2352 x 1568 pixels; 45-degree field of view; fundus photo:
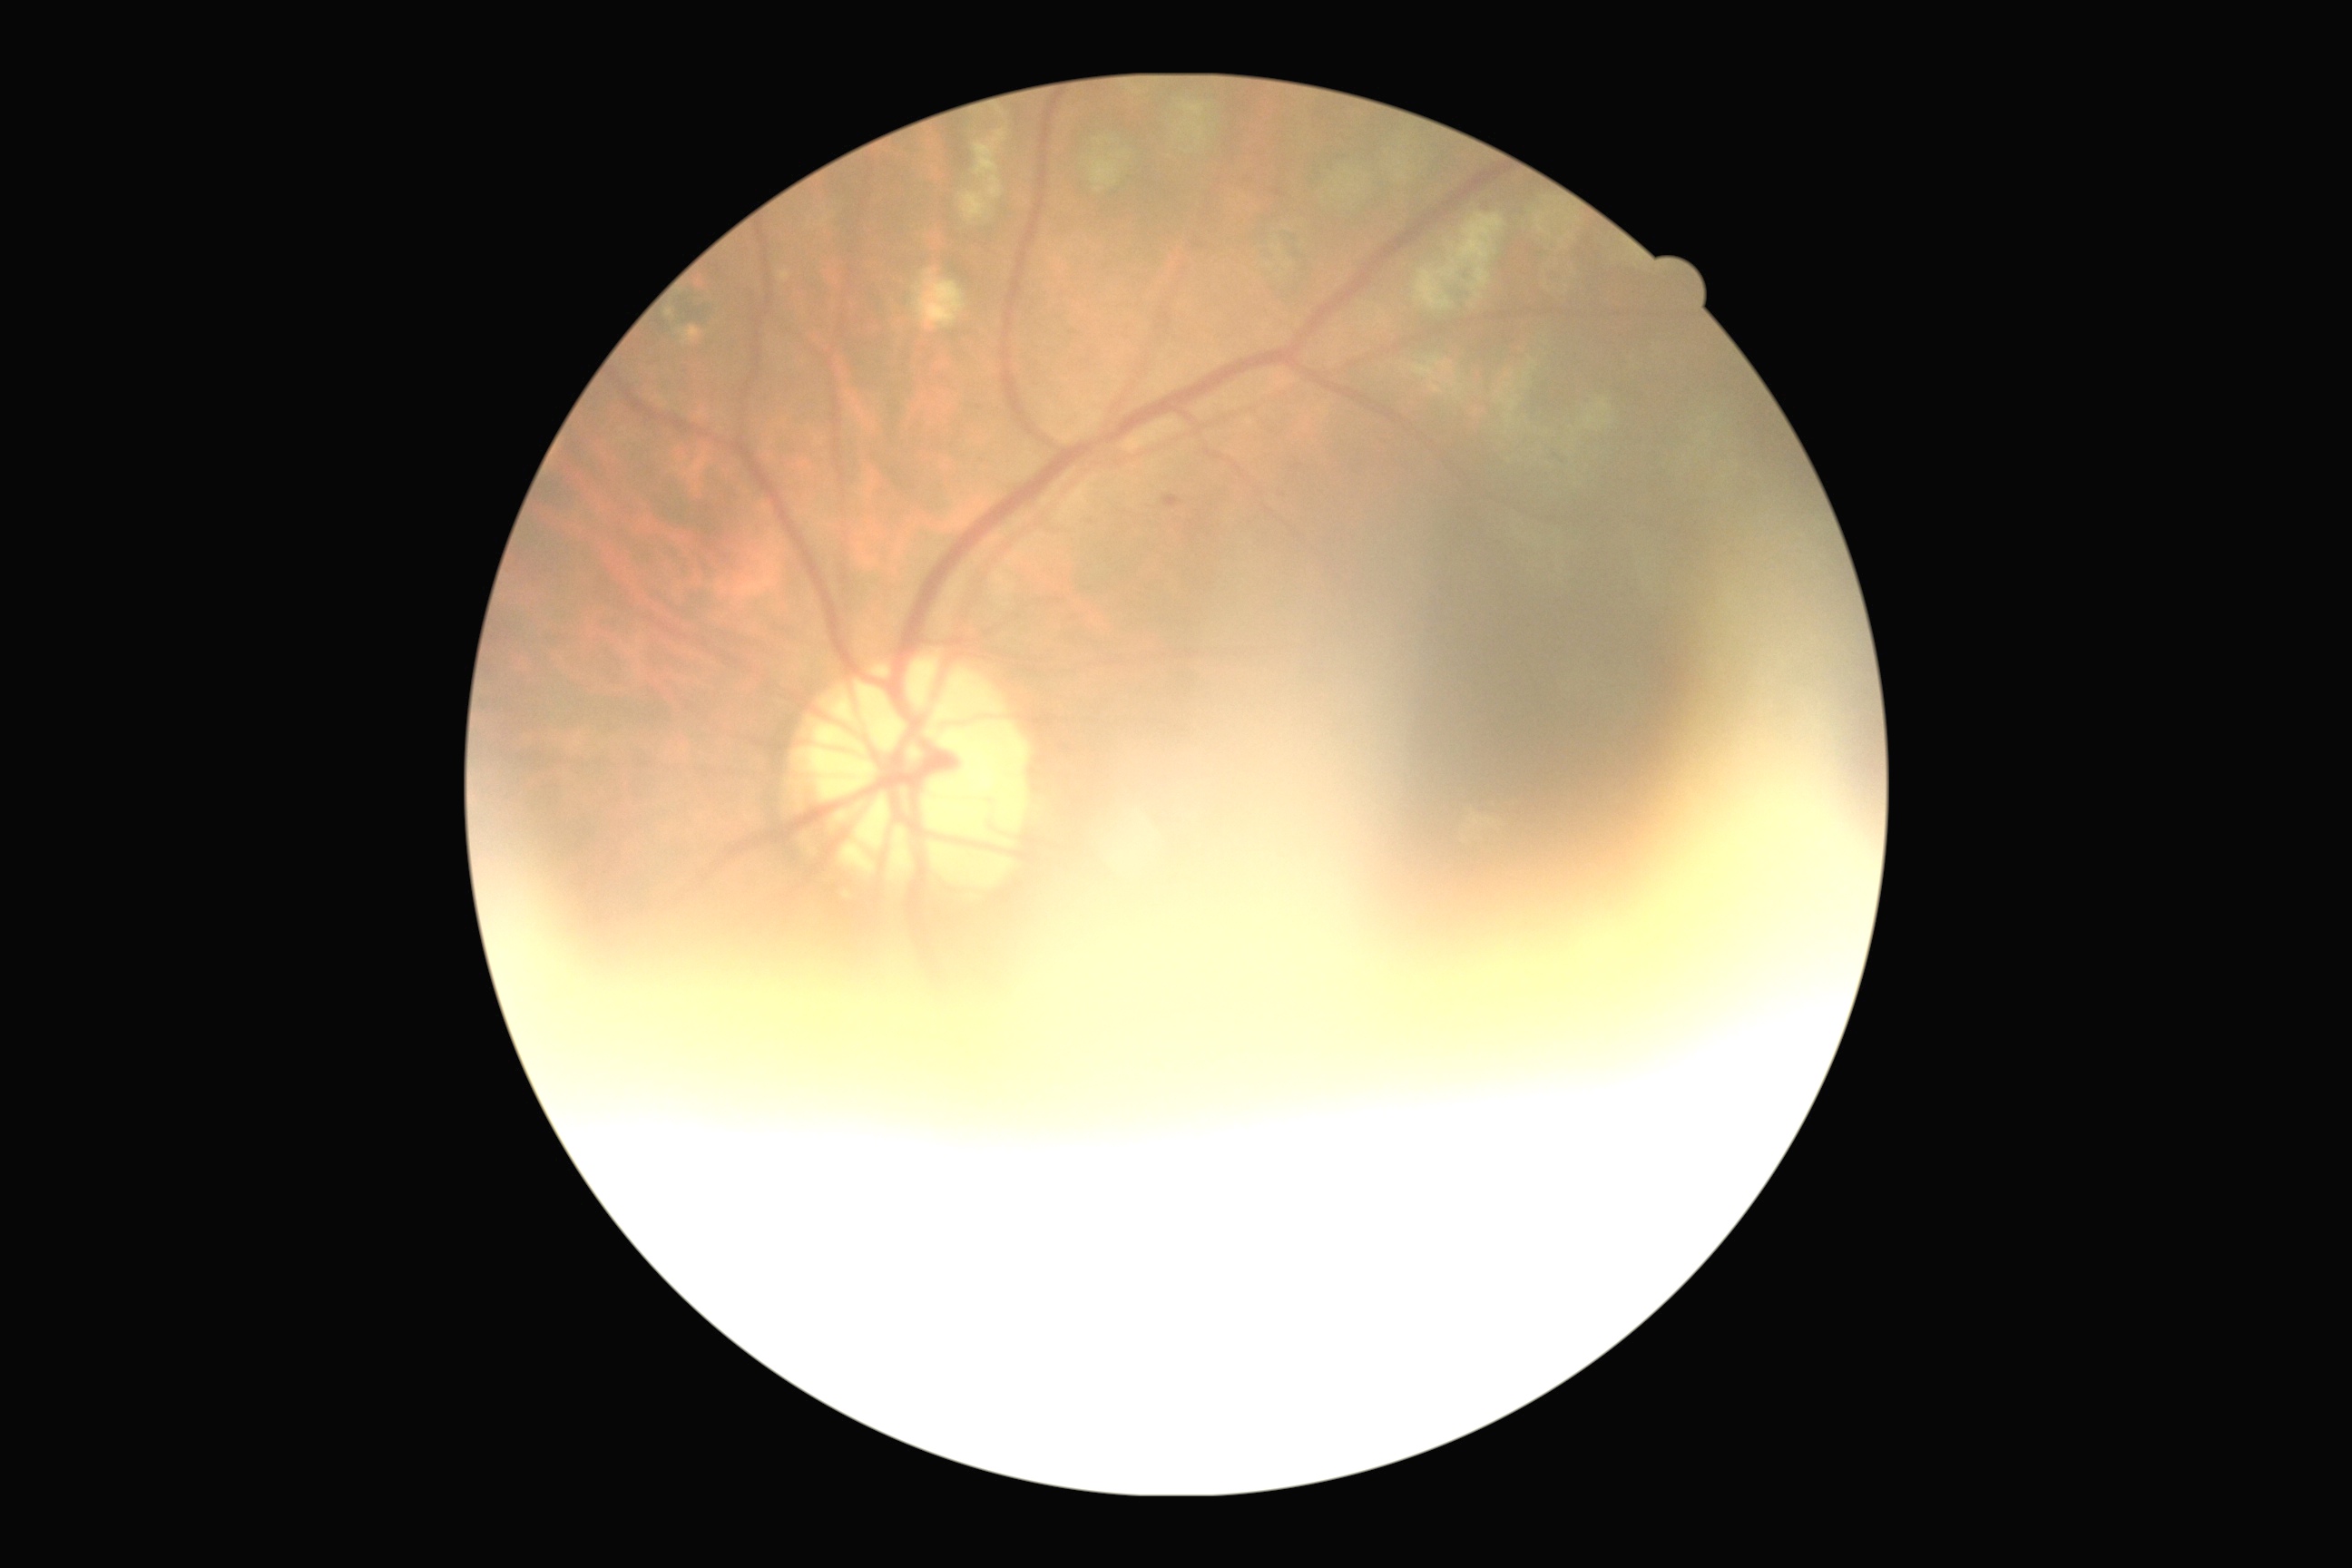

Diabetic retinopathy grade: 1 (mild NPDR).
DR class: non-proliferative diabetic retinopathy.